Retinal fundus photograph.
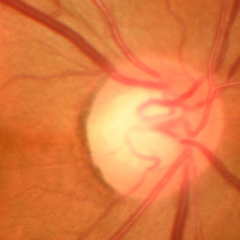 Assessment: early glaucomatous changes. (Criteria: glaucomatous retinal nerve fiber layer defects on red-free fundus photography without visual field defects.)